45° field of view; color fundus image:
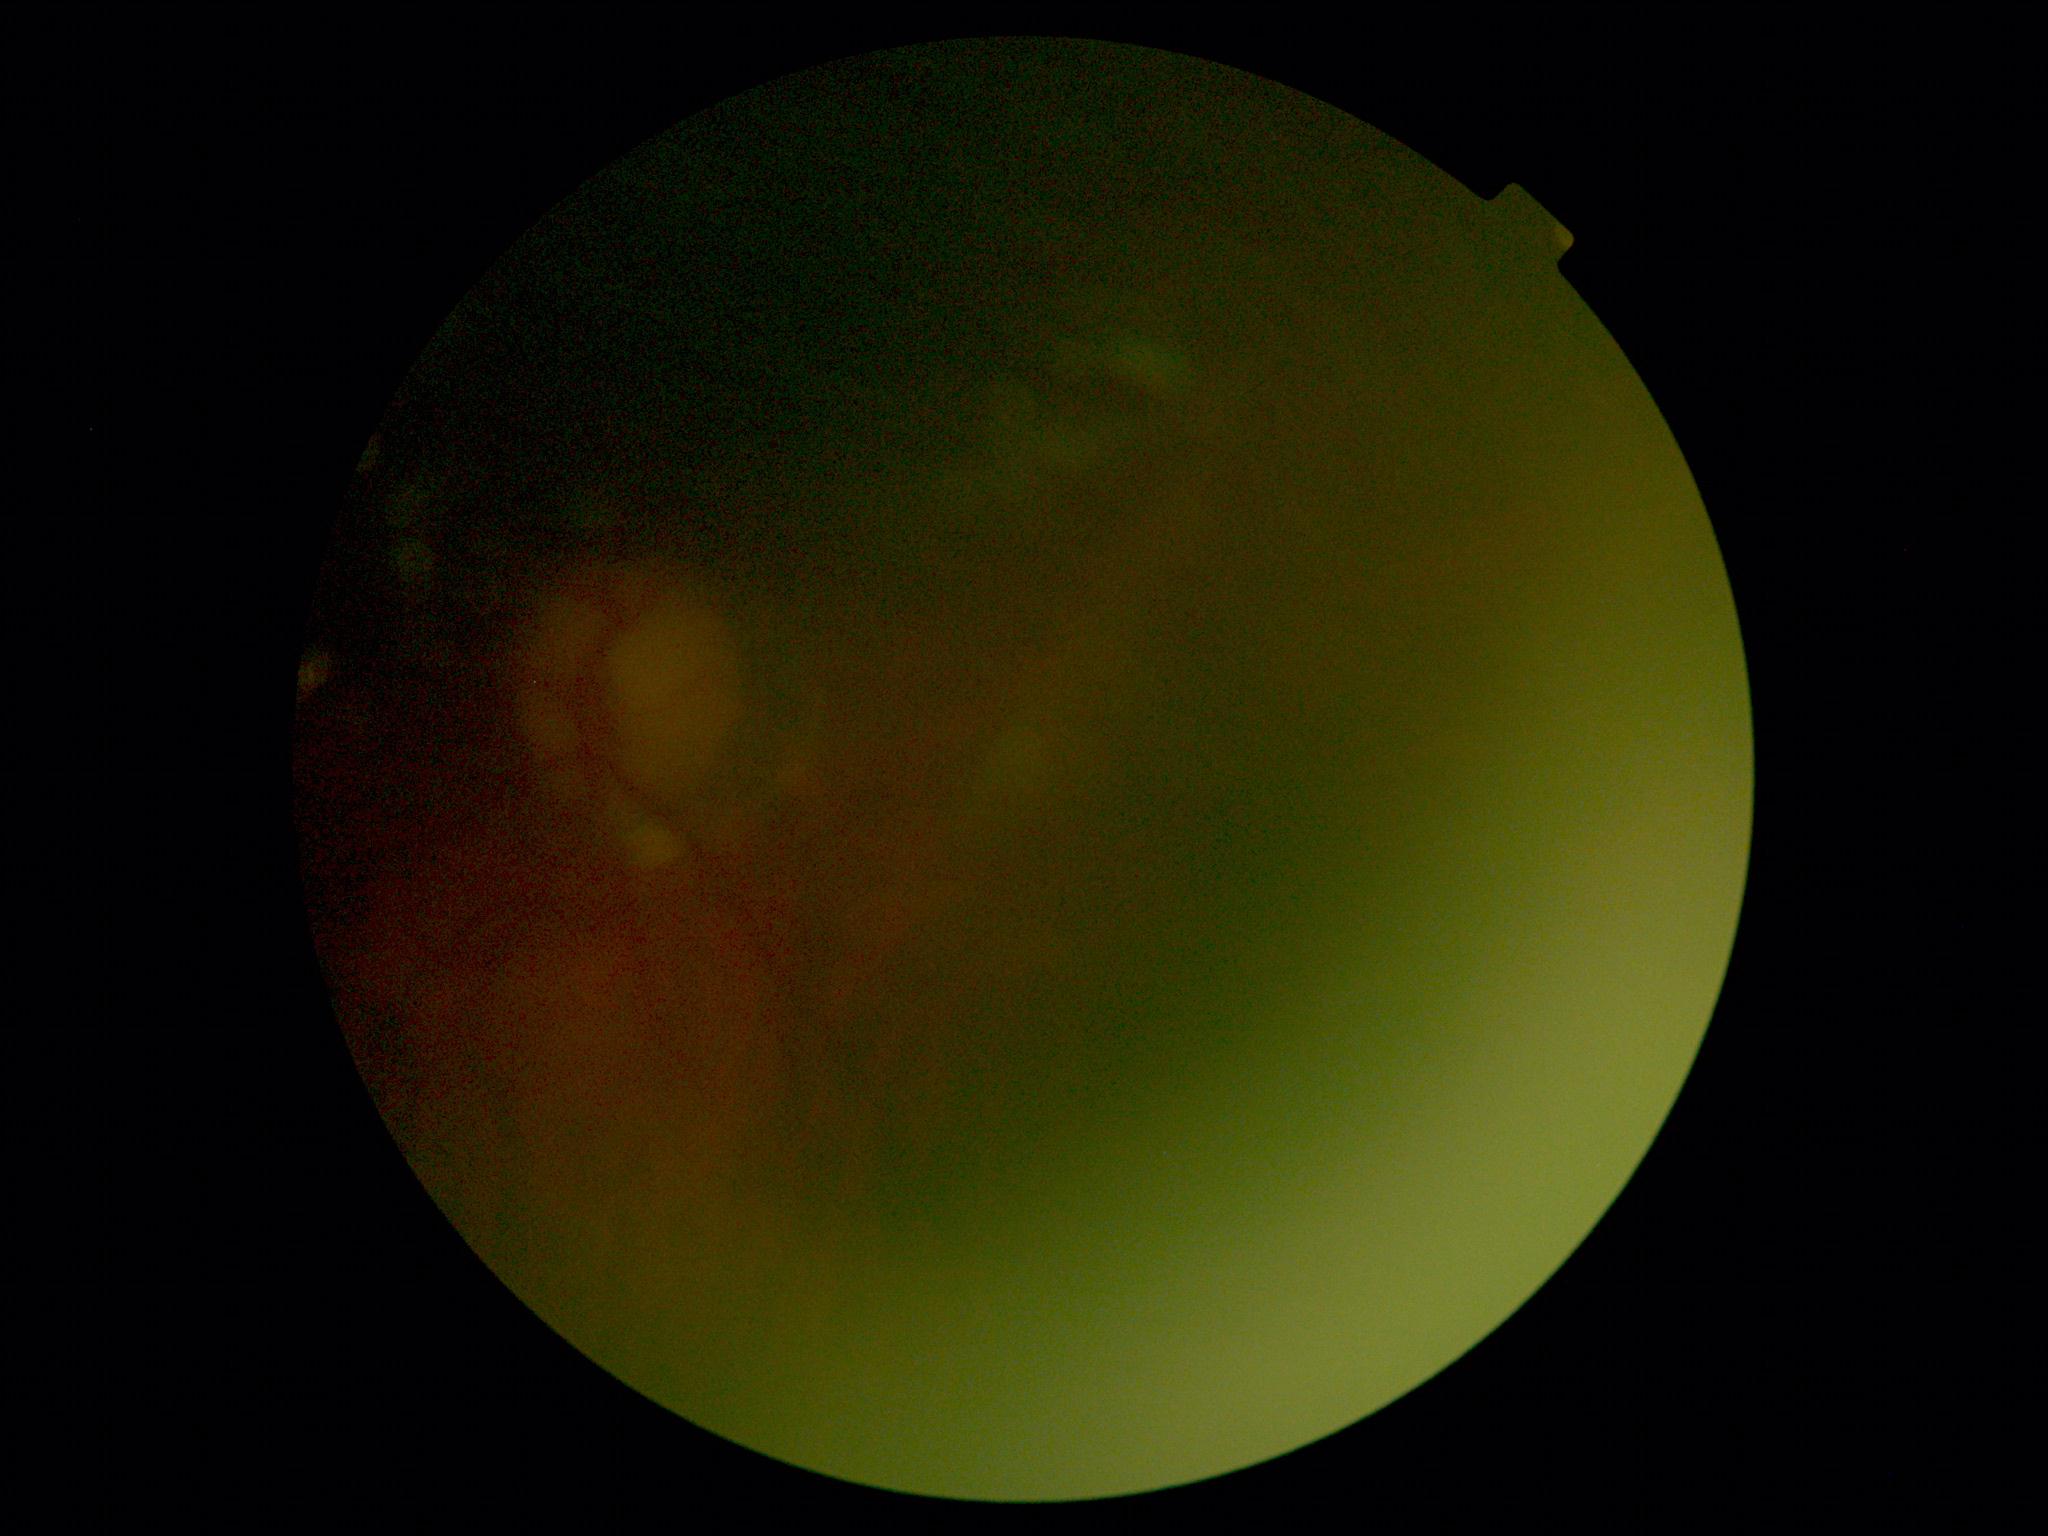 Annotations:
- DR: ungradable